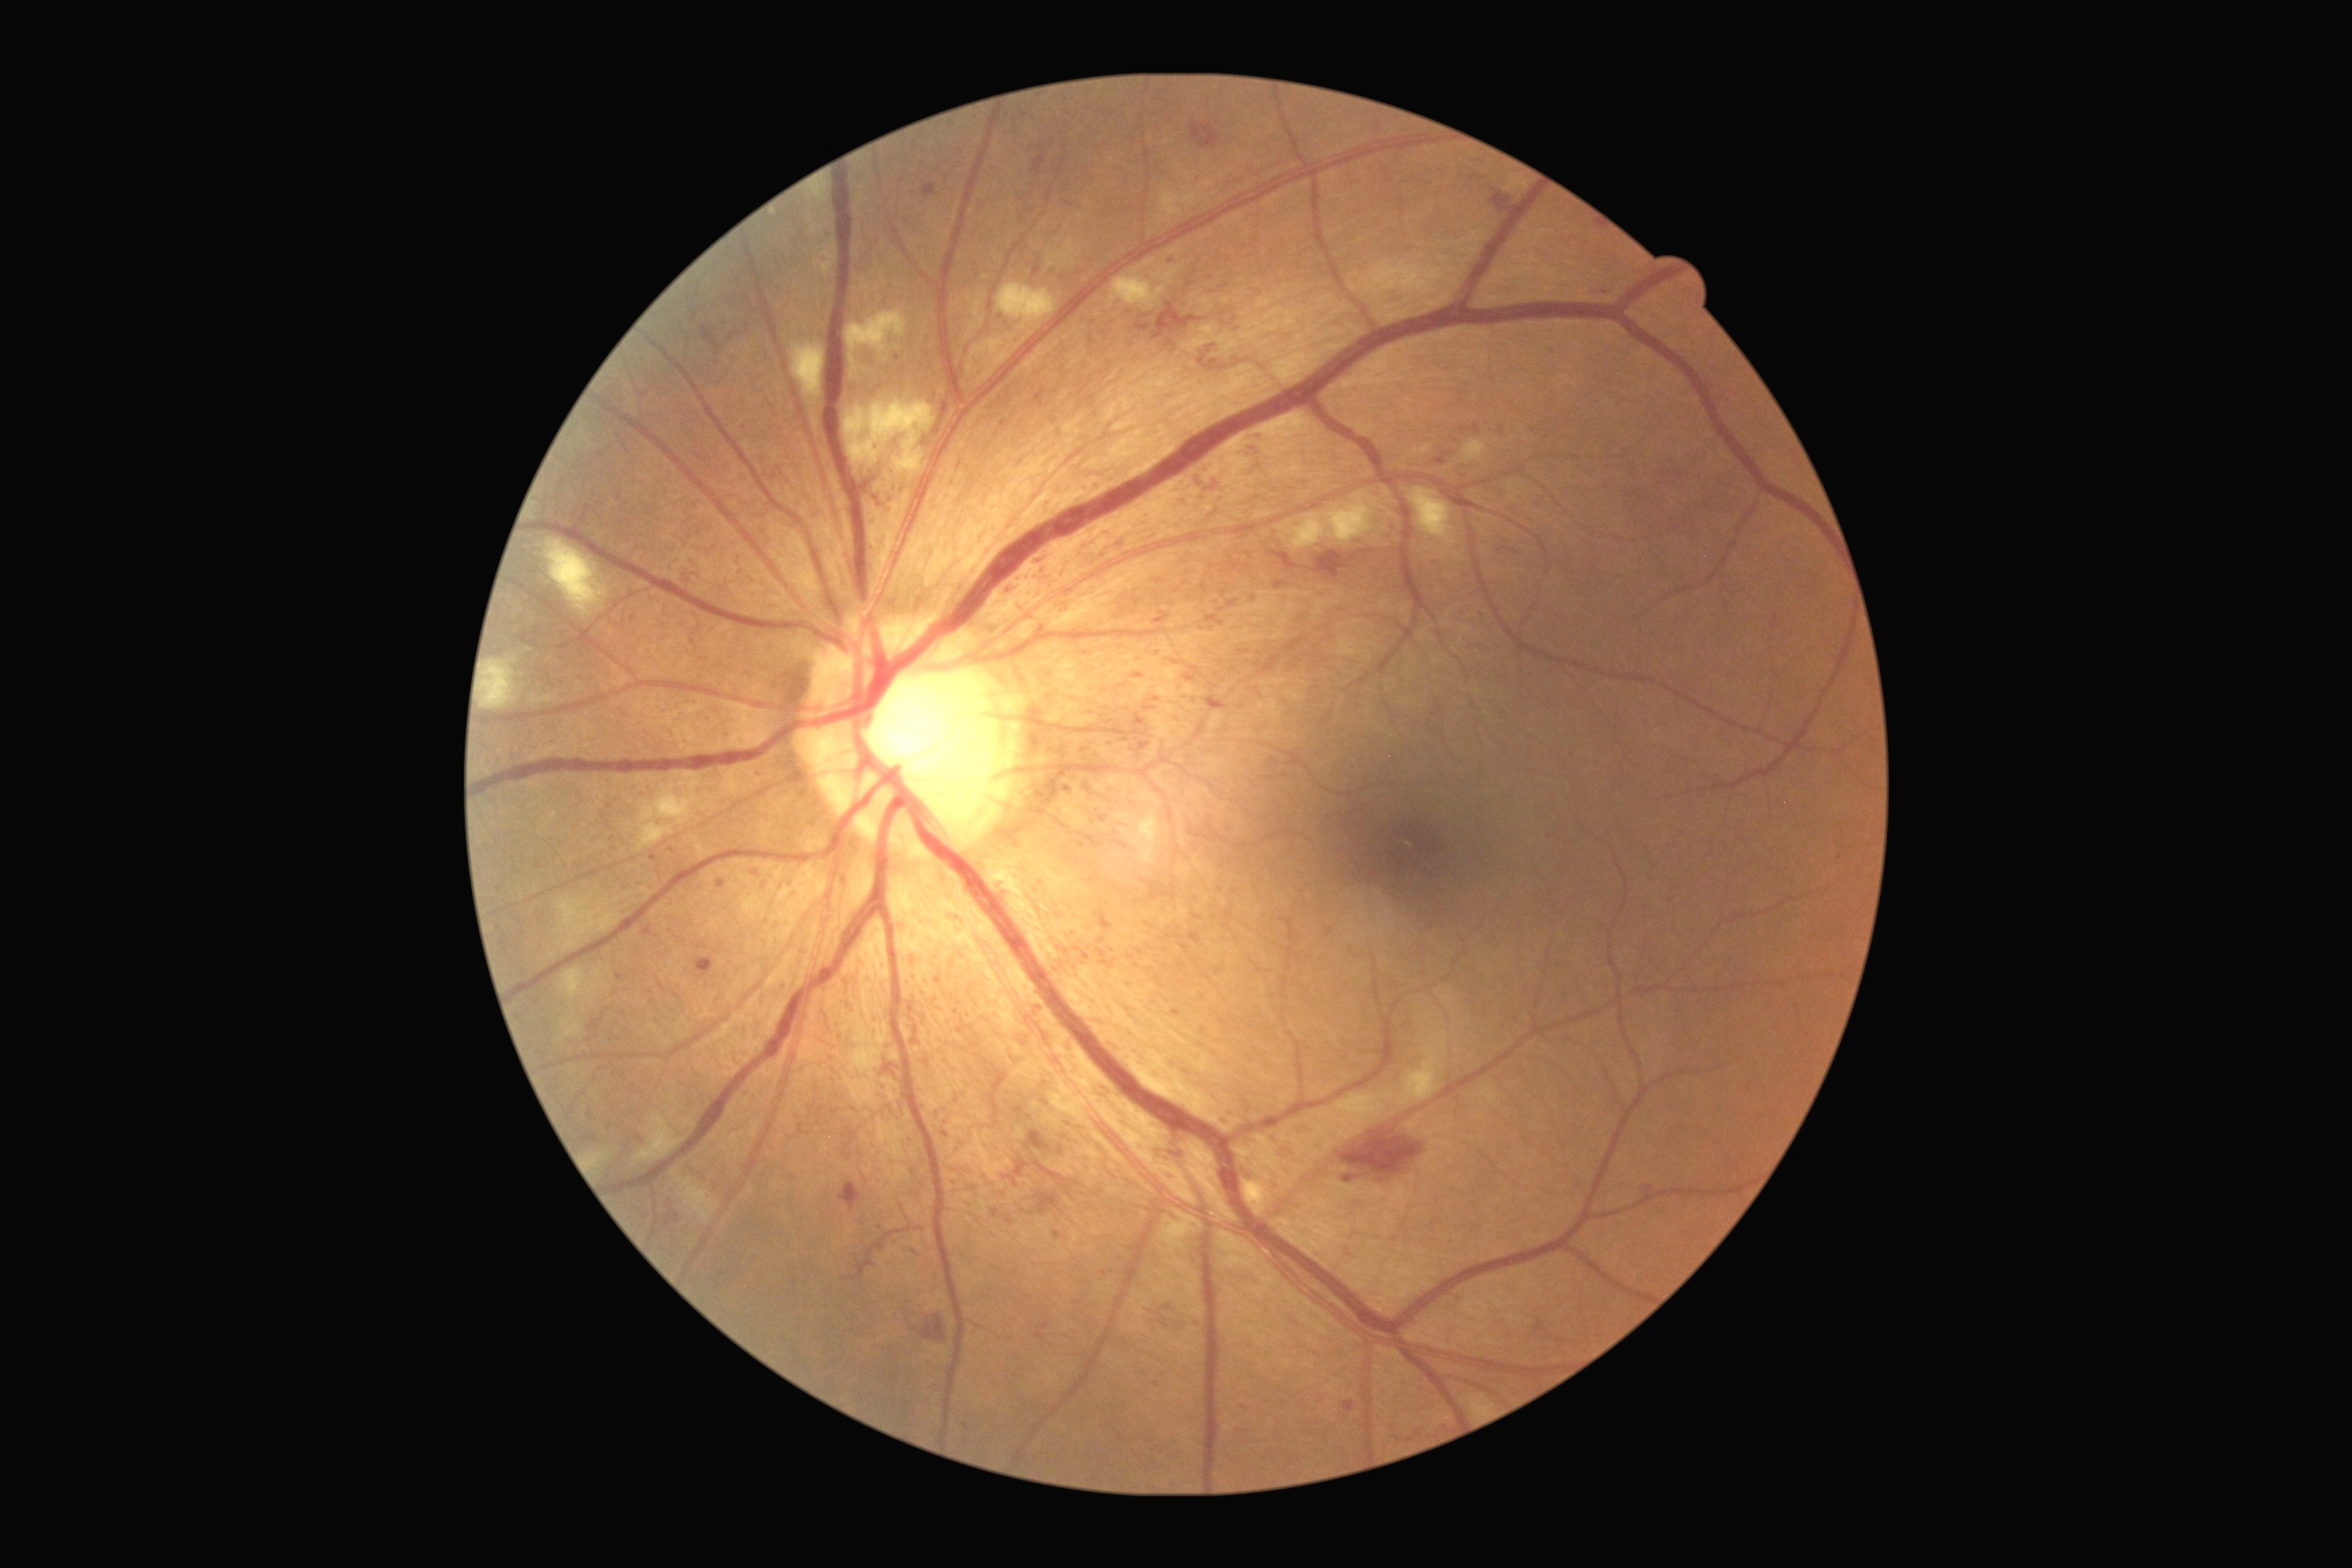 <lesions partial="true">
  <dr_grade>3</dr_grade>
  <ma partial="true">box(1473, 426, 1480, 435), box(1097, 950, 1106, 959), box(1220, 1019, 1230, 1024), box(1228, 600, 1239, 609), box(1200, 583, 1208, 594), box(923, 184, 937, 199), box(1155, 612, 1170, 623), box(992, 1210, 999, 1219)</ma>
  <ma_small_centers>point(1436, 564), point(1211, 278), point(945, 1134), point(1167, 1307), point(1004, 1195), point(1118, 617), point(1196, 917), point(793, 1179), point(1225, 593)</ma_small_centers>
</lesions>